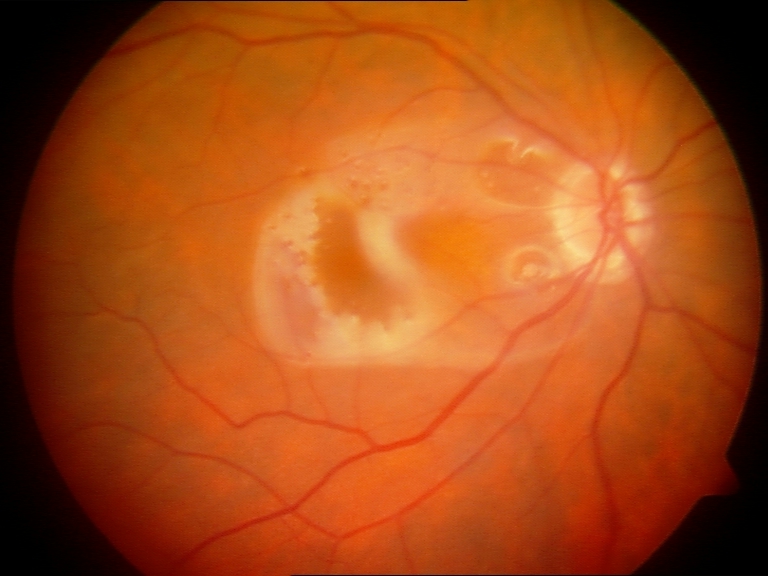
Findings: silicone oil in the eye.